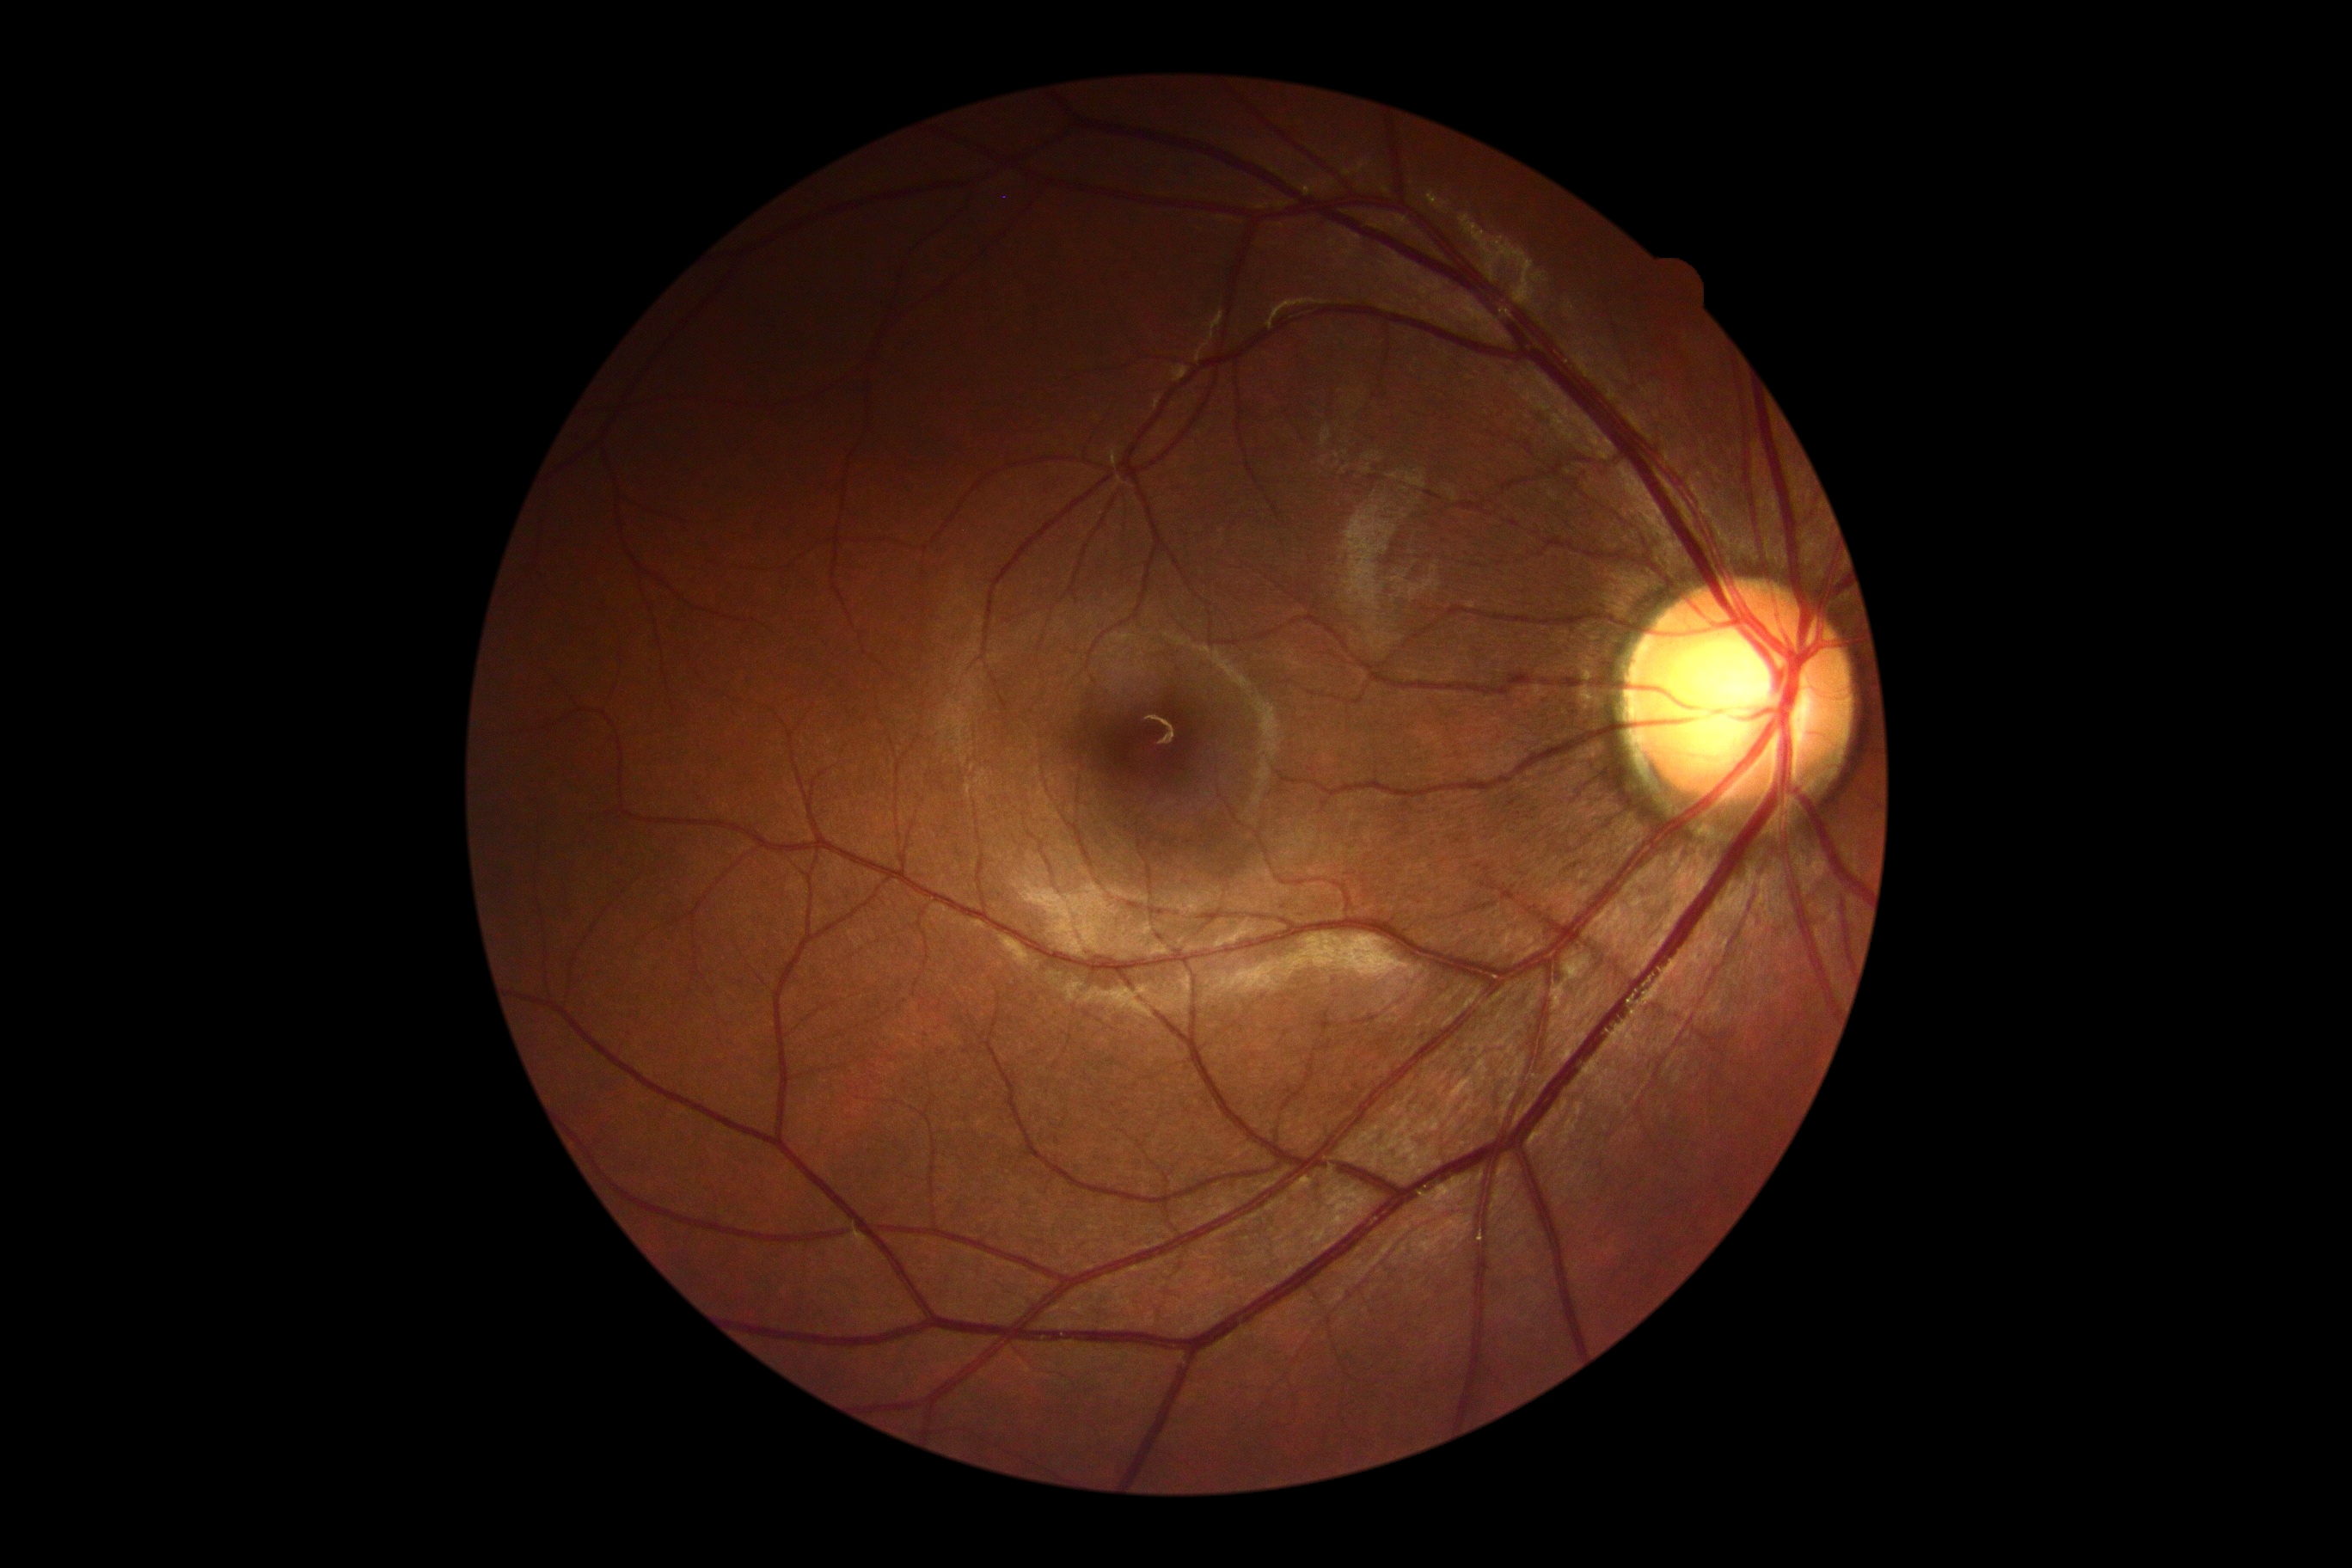

No signs of diabetic retinopathy. Diabetic retinopathy (DR): no apparent retinopathy (grade 0).